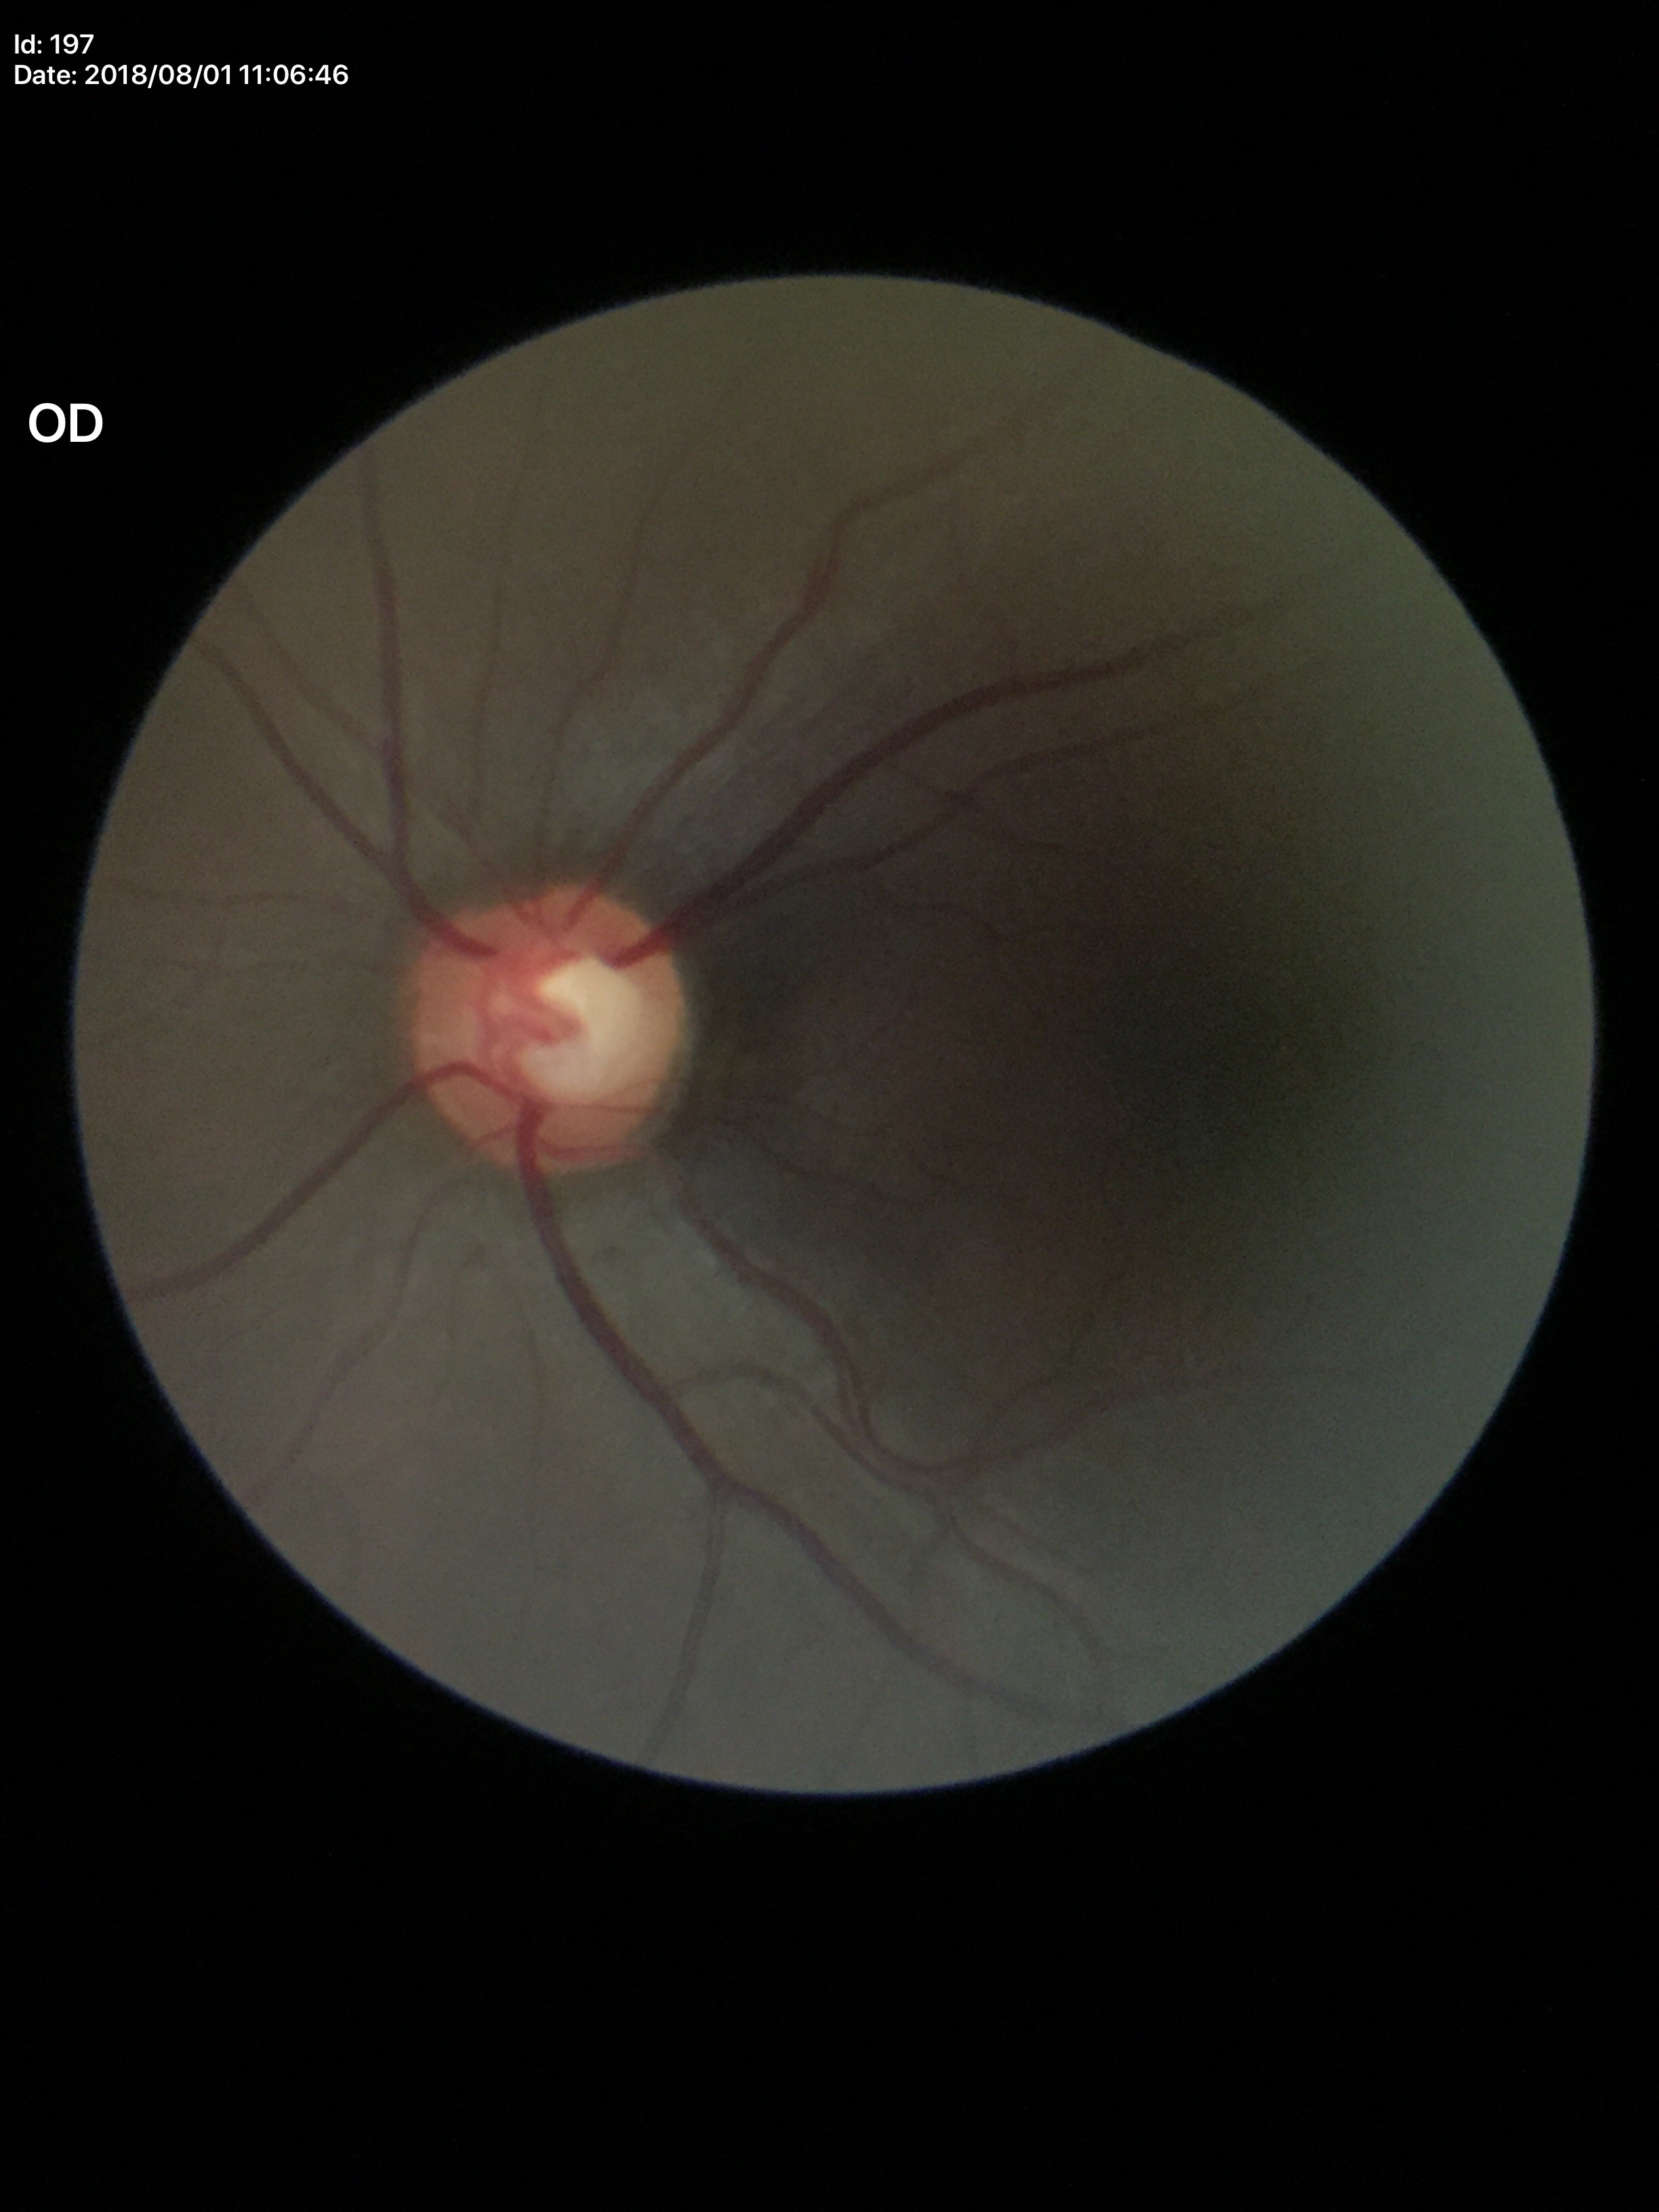 Glaucoma decision: suspicious findings. Vertical CDR is 0.59.